100° field of view (Phoenix ICON); 1240 by 1240 pixels; infant wide-field retinal image.
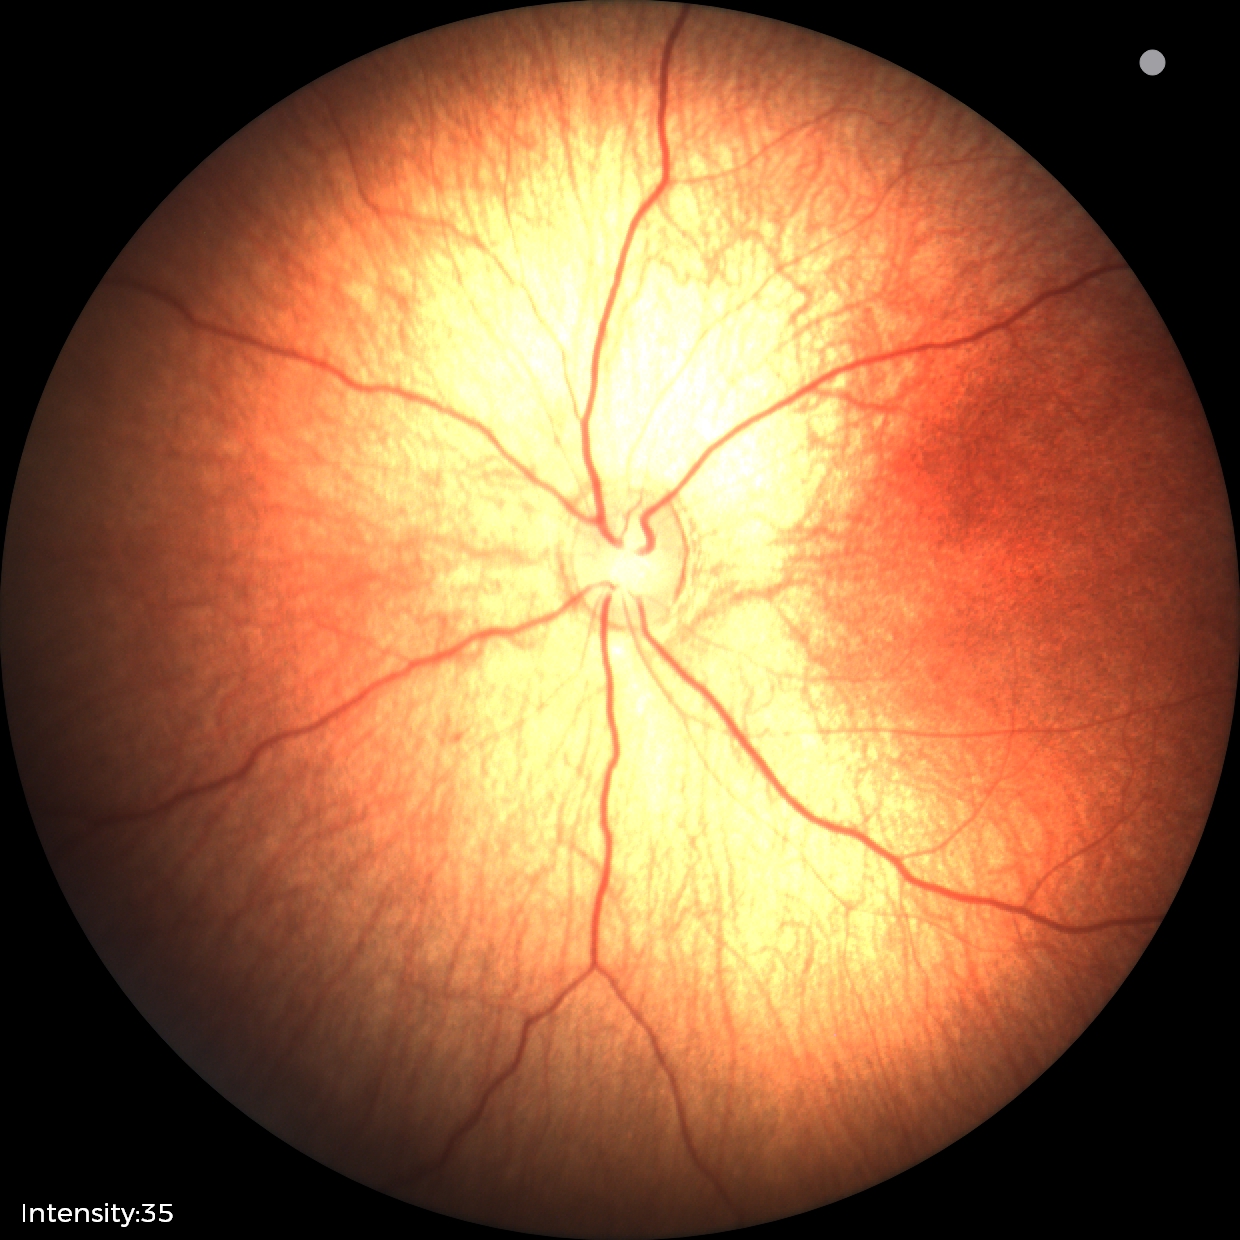
Q: What is the diagnosis from this examination?
A: normal retinal appearance